Color fundus image. 45° FOV — 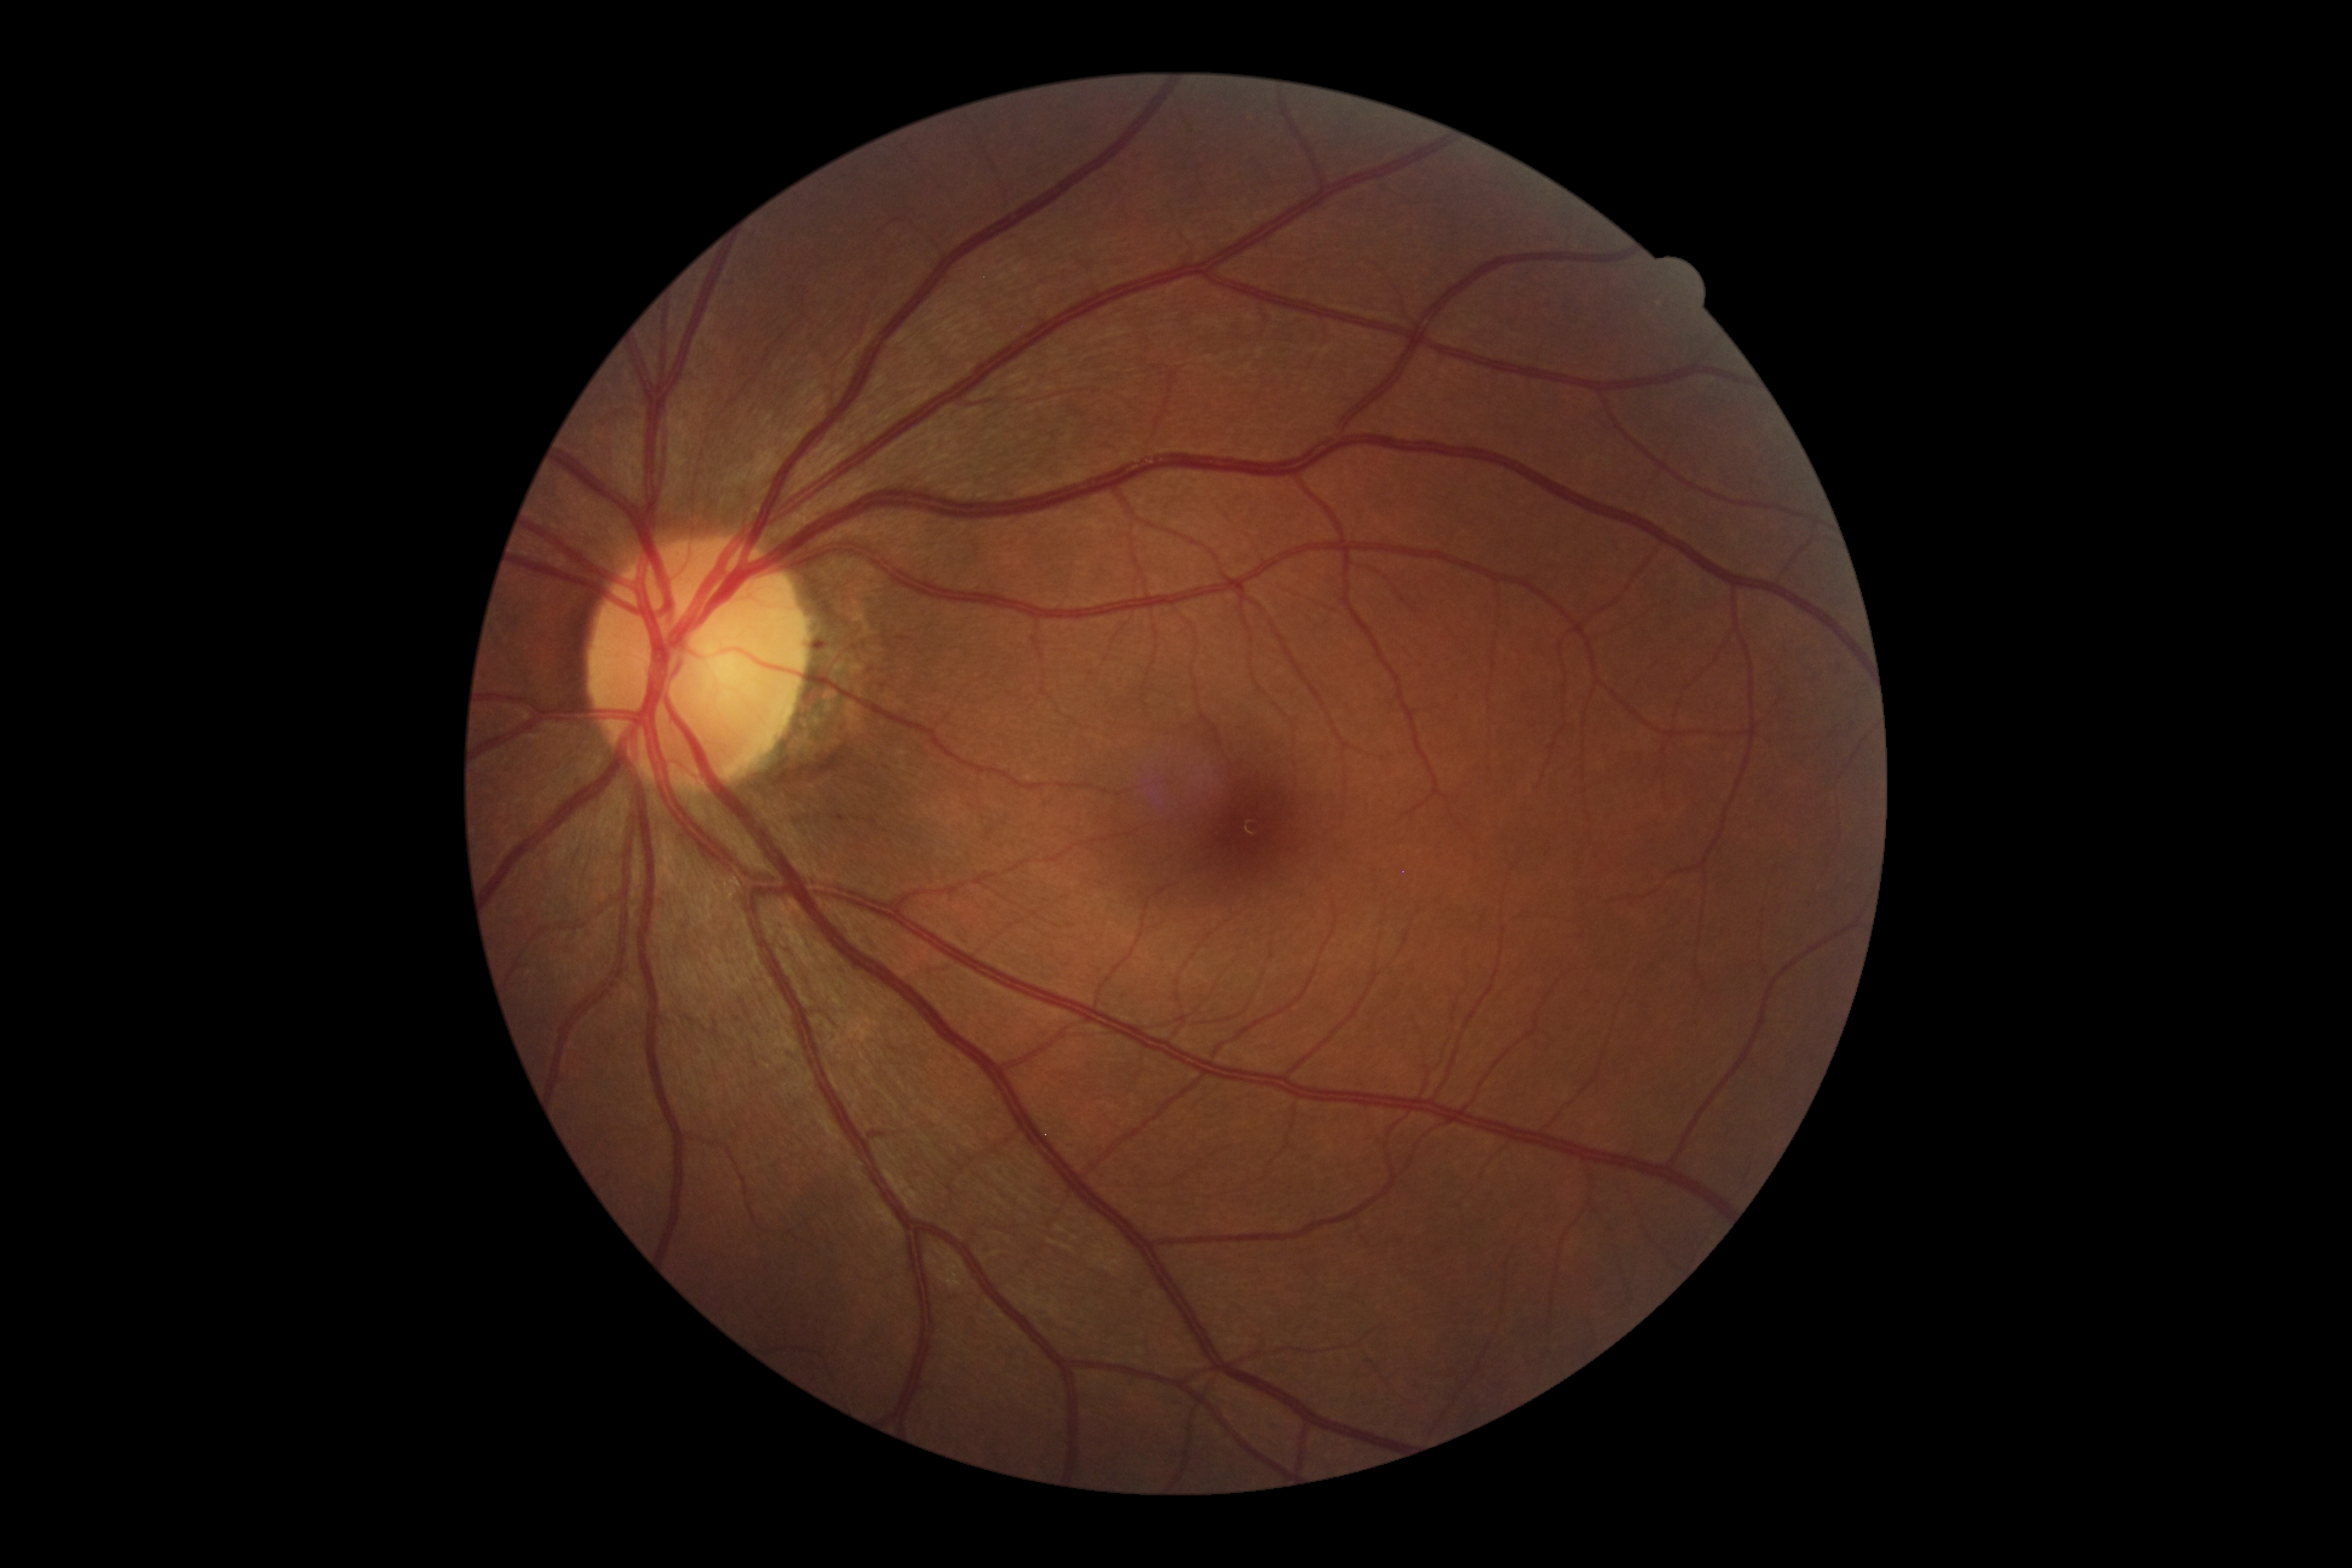

DR stage: 1/4.
No HEs identified.
No EXs identified.
No SEs identified.
MAs at l=814, t=642, r=825, b=648.